45-degree field of view · CFP
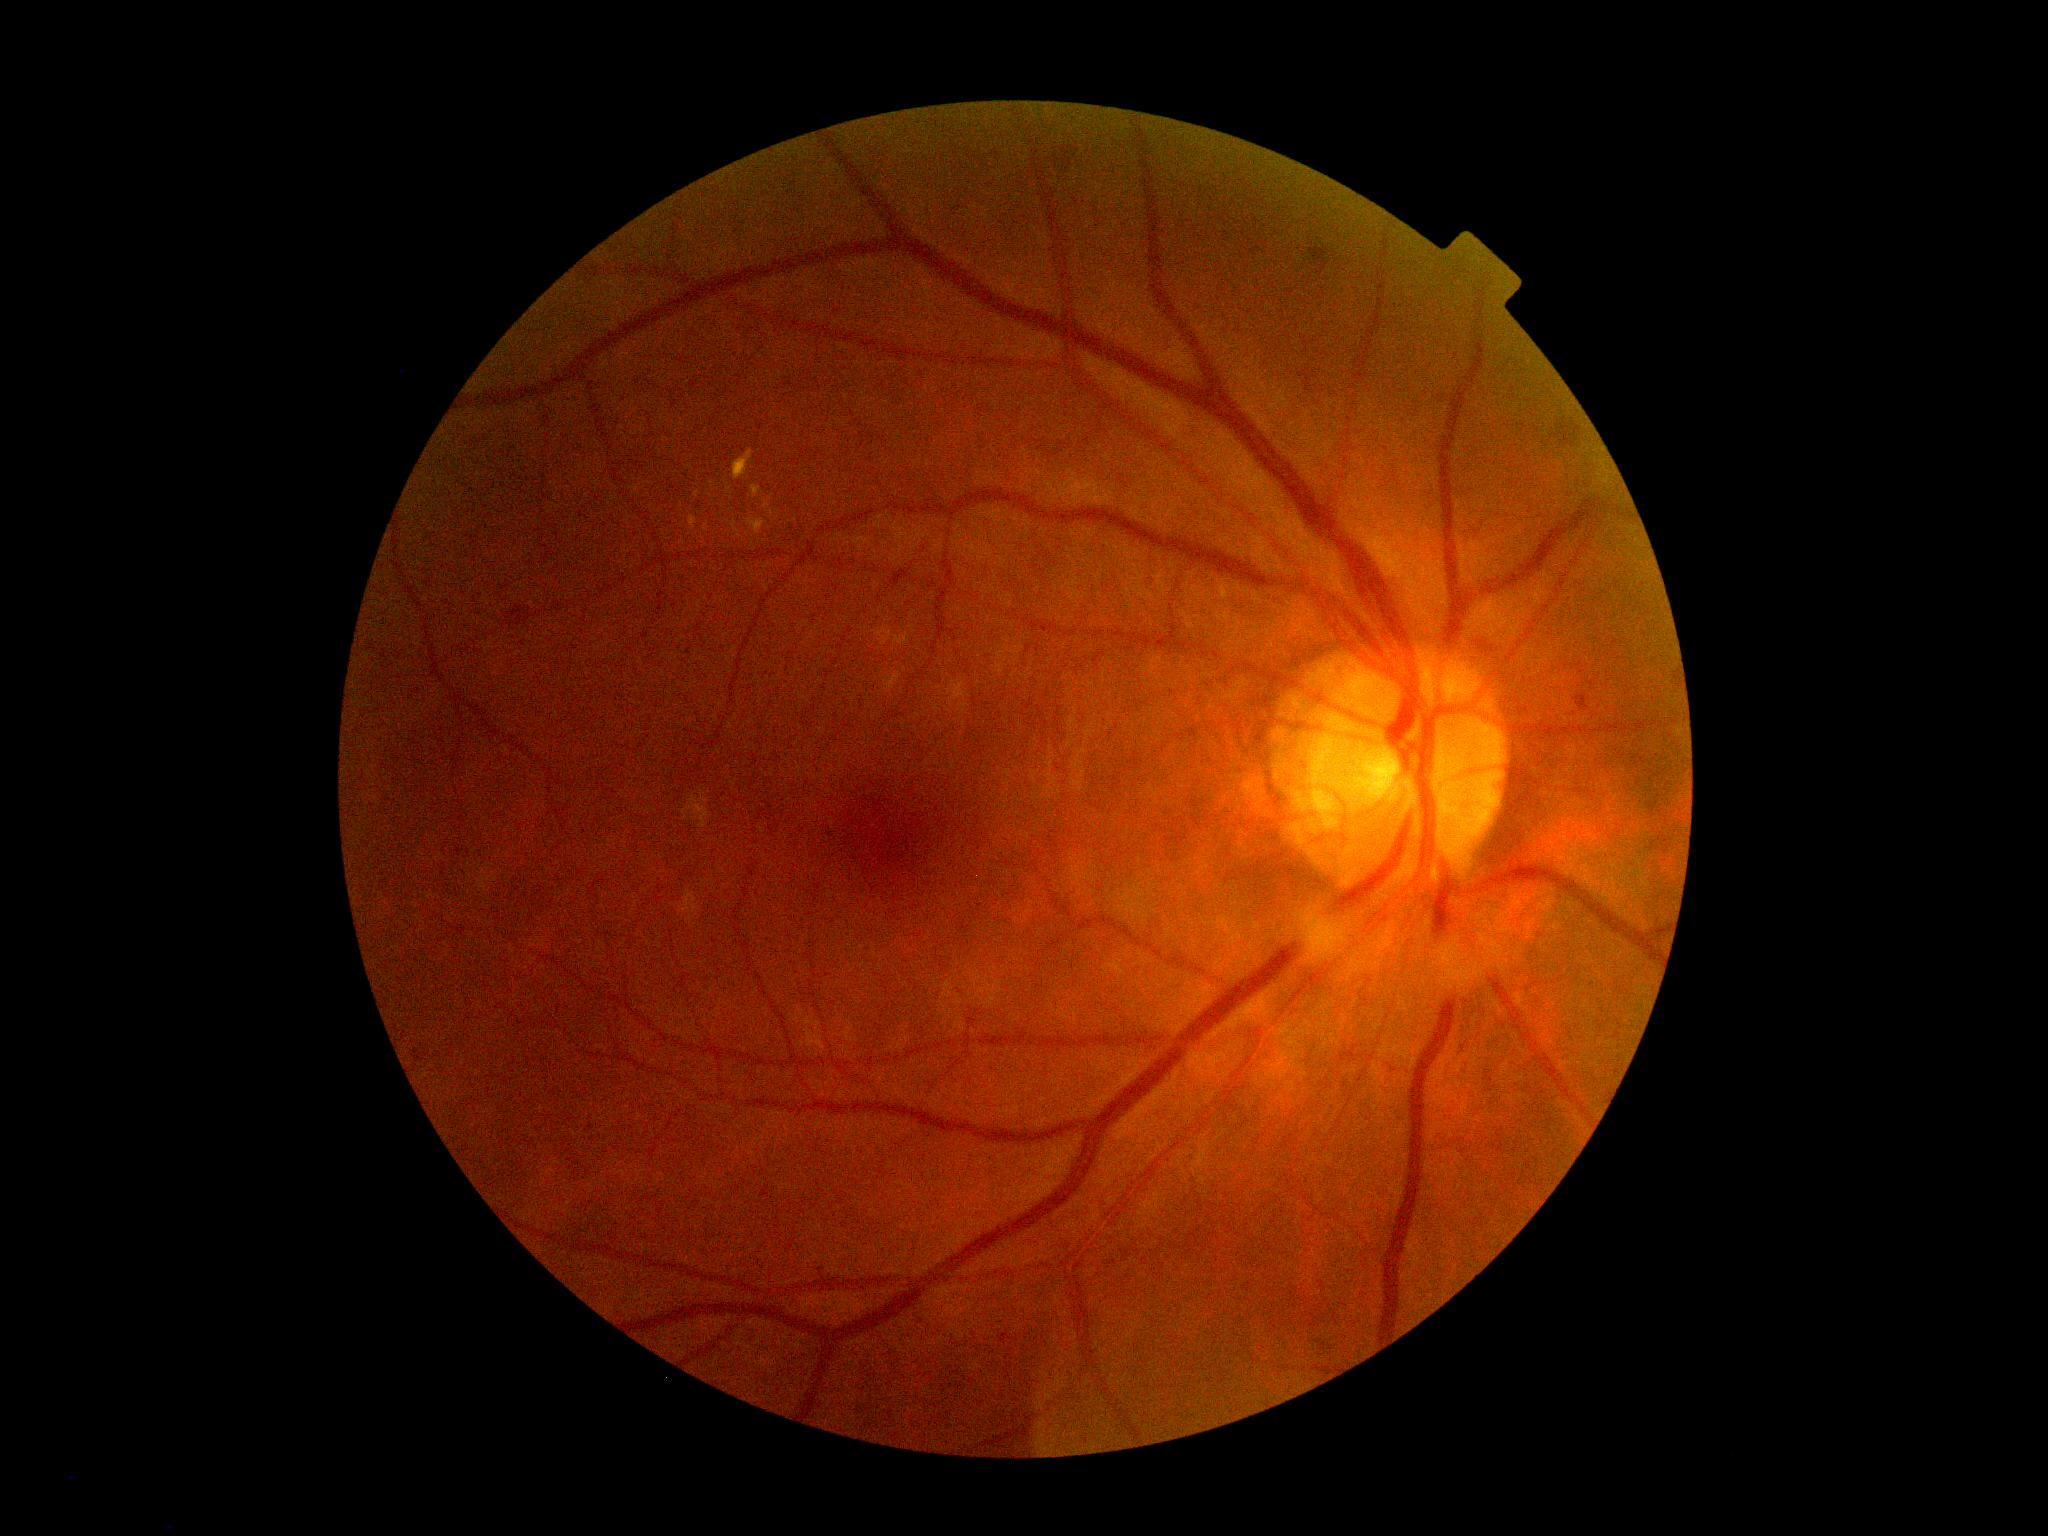
dr_category: non-proliferative diabetic retinopathy
dr_grade: grade 2